Camera: Nidek AFC-330
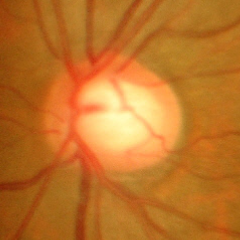

Glaucoma status: no evidence of glaucoma.